Fundus photo: 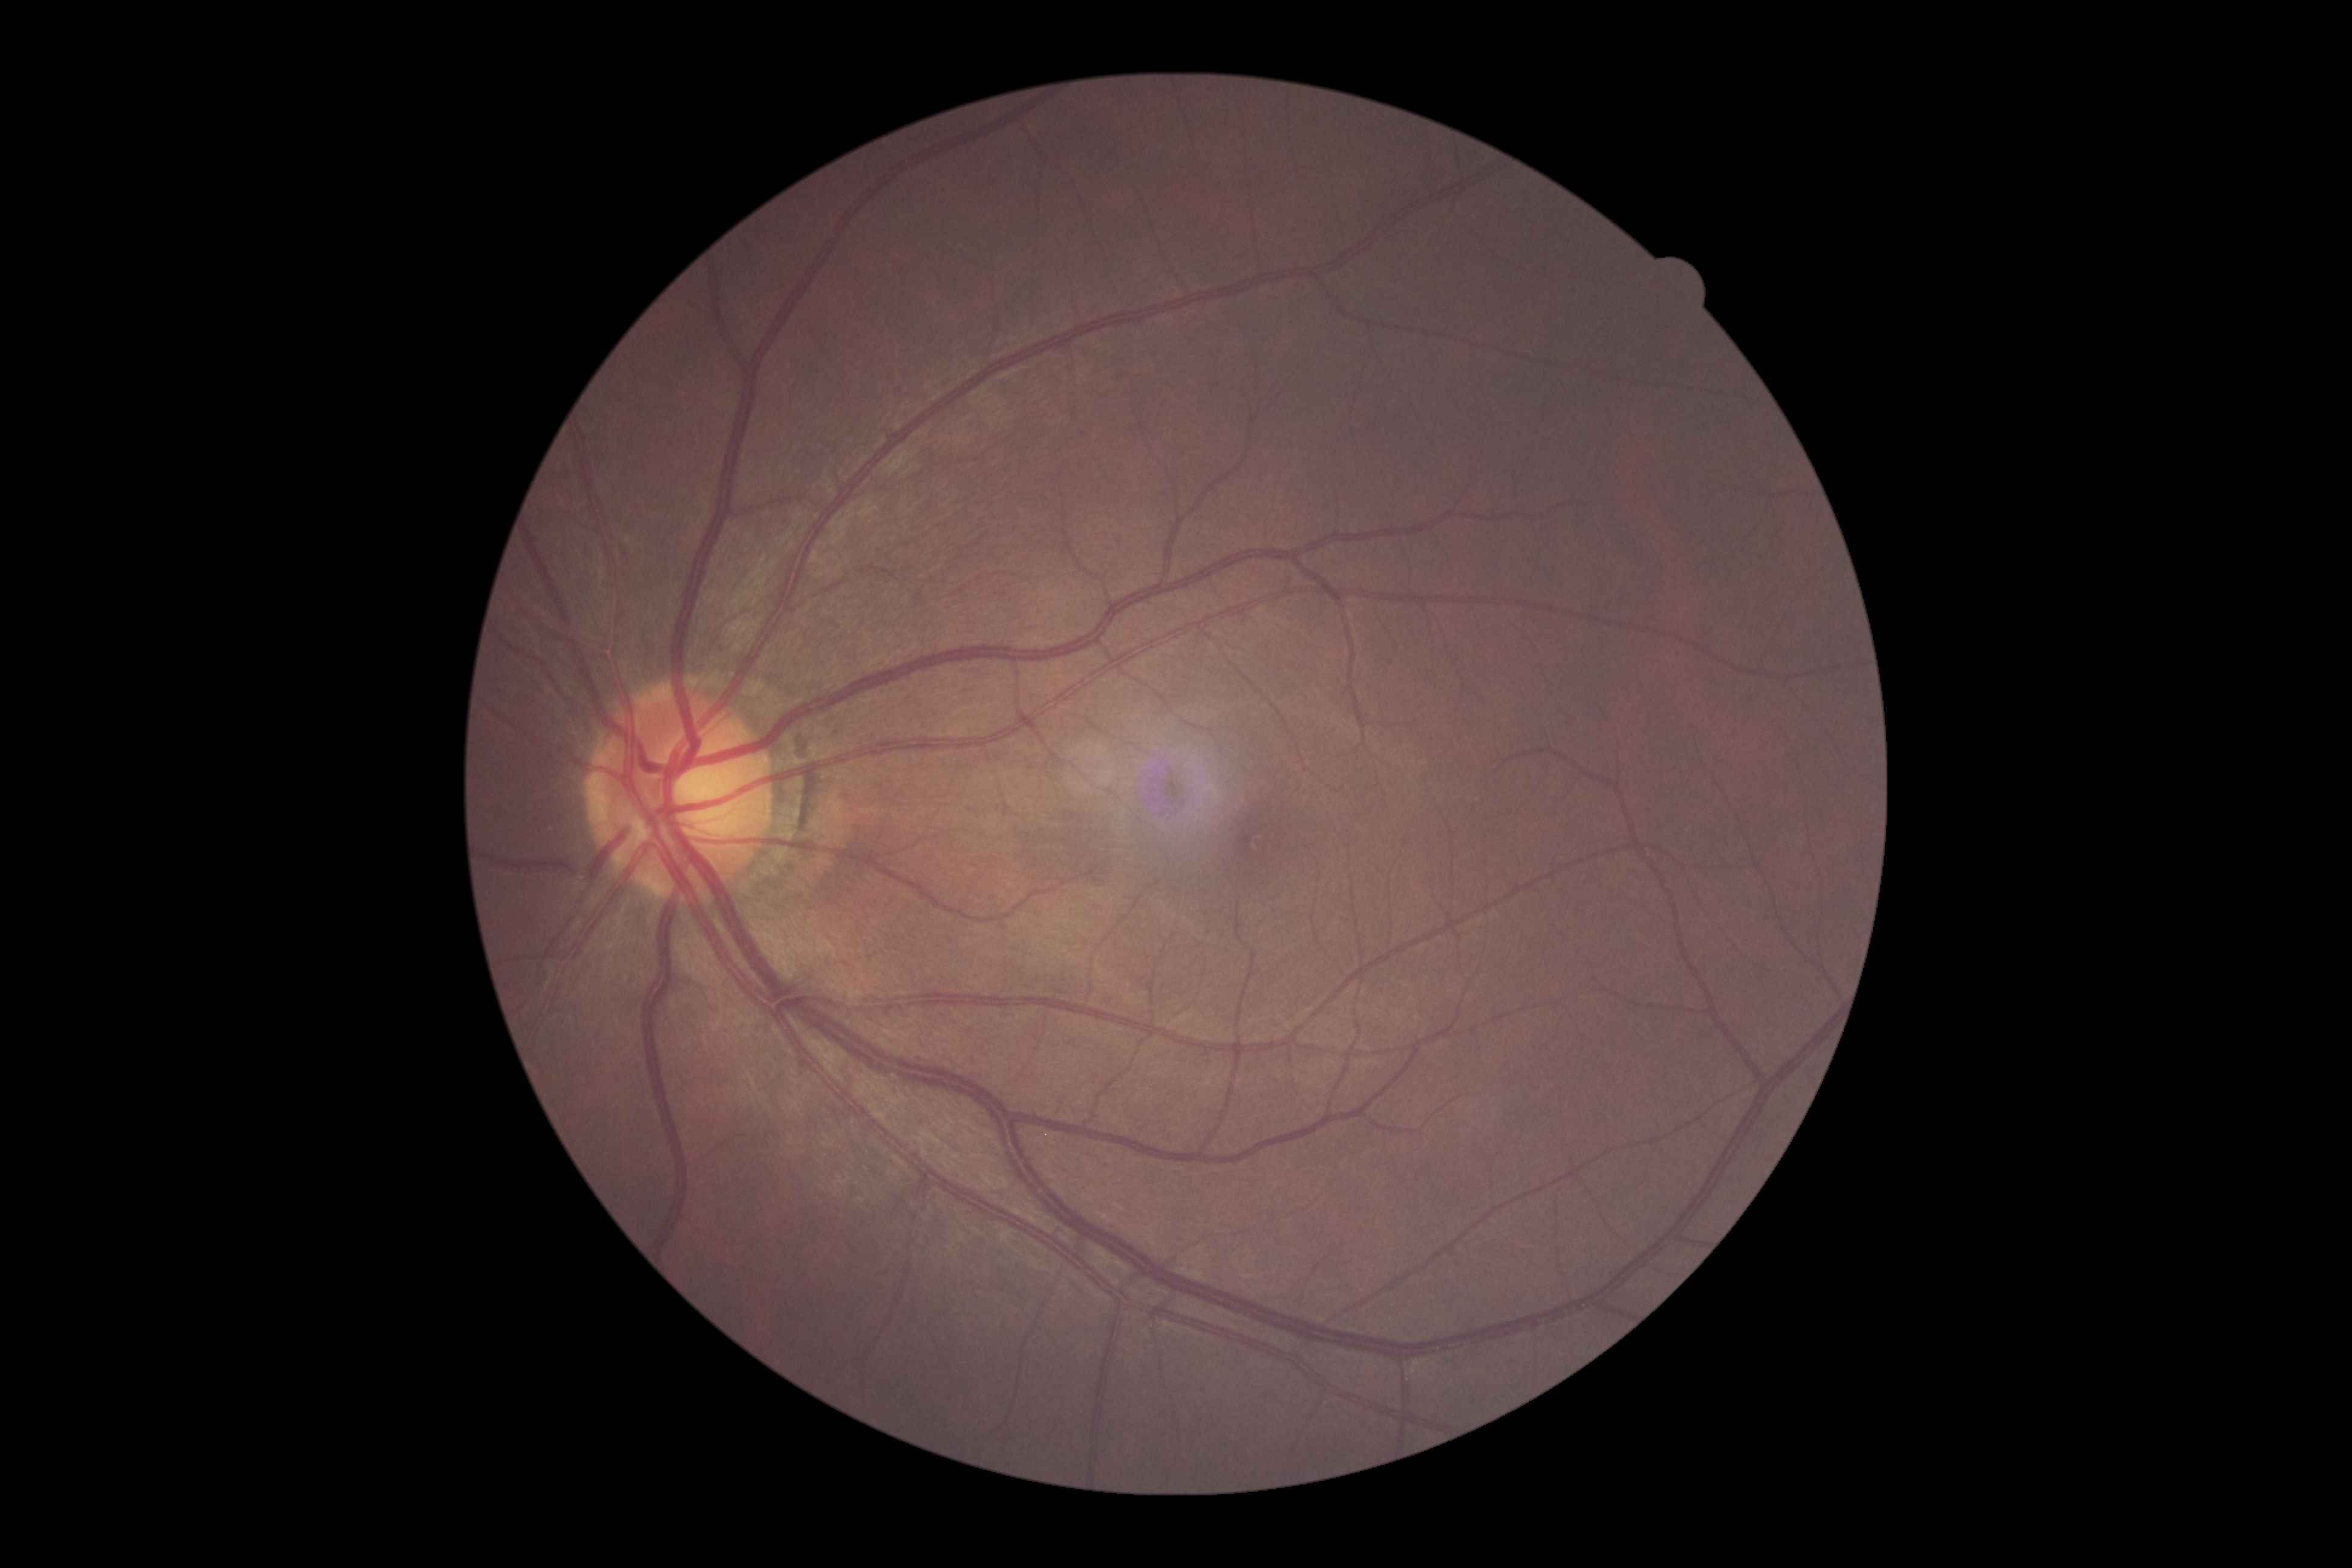 diabetic retinopathy grade=0 — no visible signs of diabetic retinopathy; DR impression=no signs of DR.